CFP; 848 x 848 pixels: 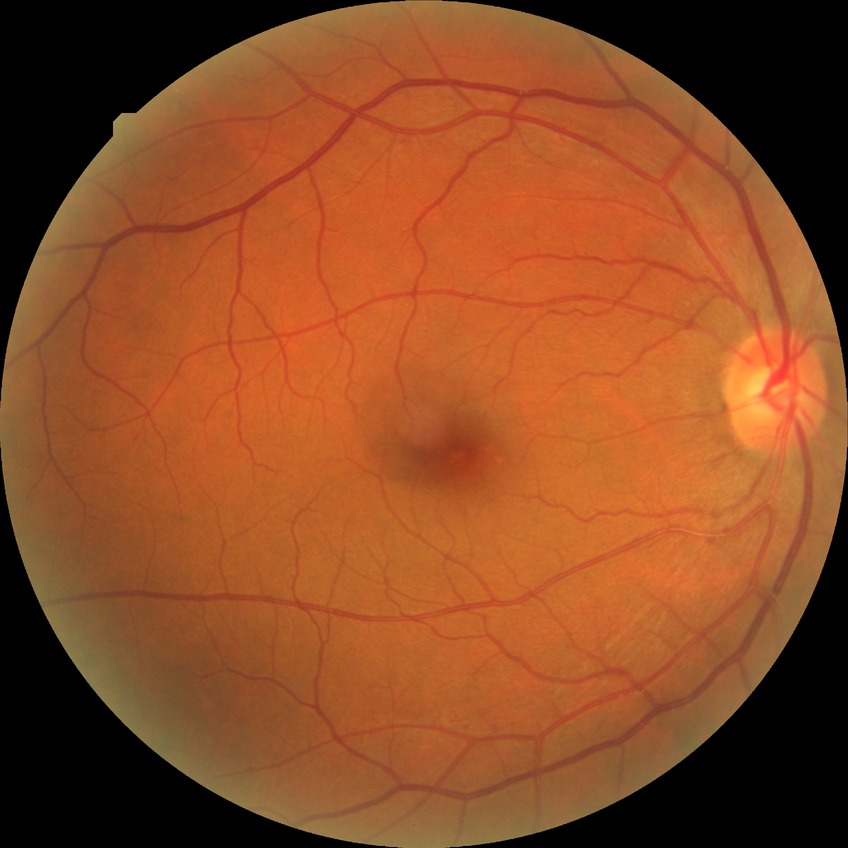

Diabetic retinopathy (DR) is no diabetic retinopathy (NDR).